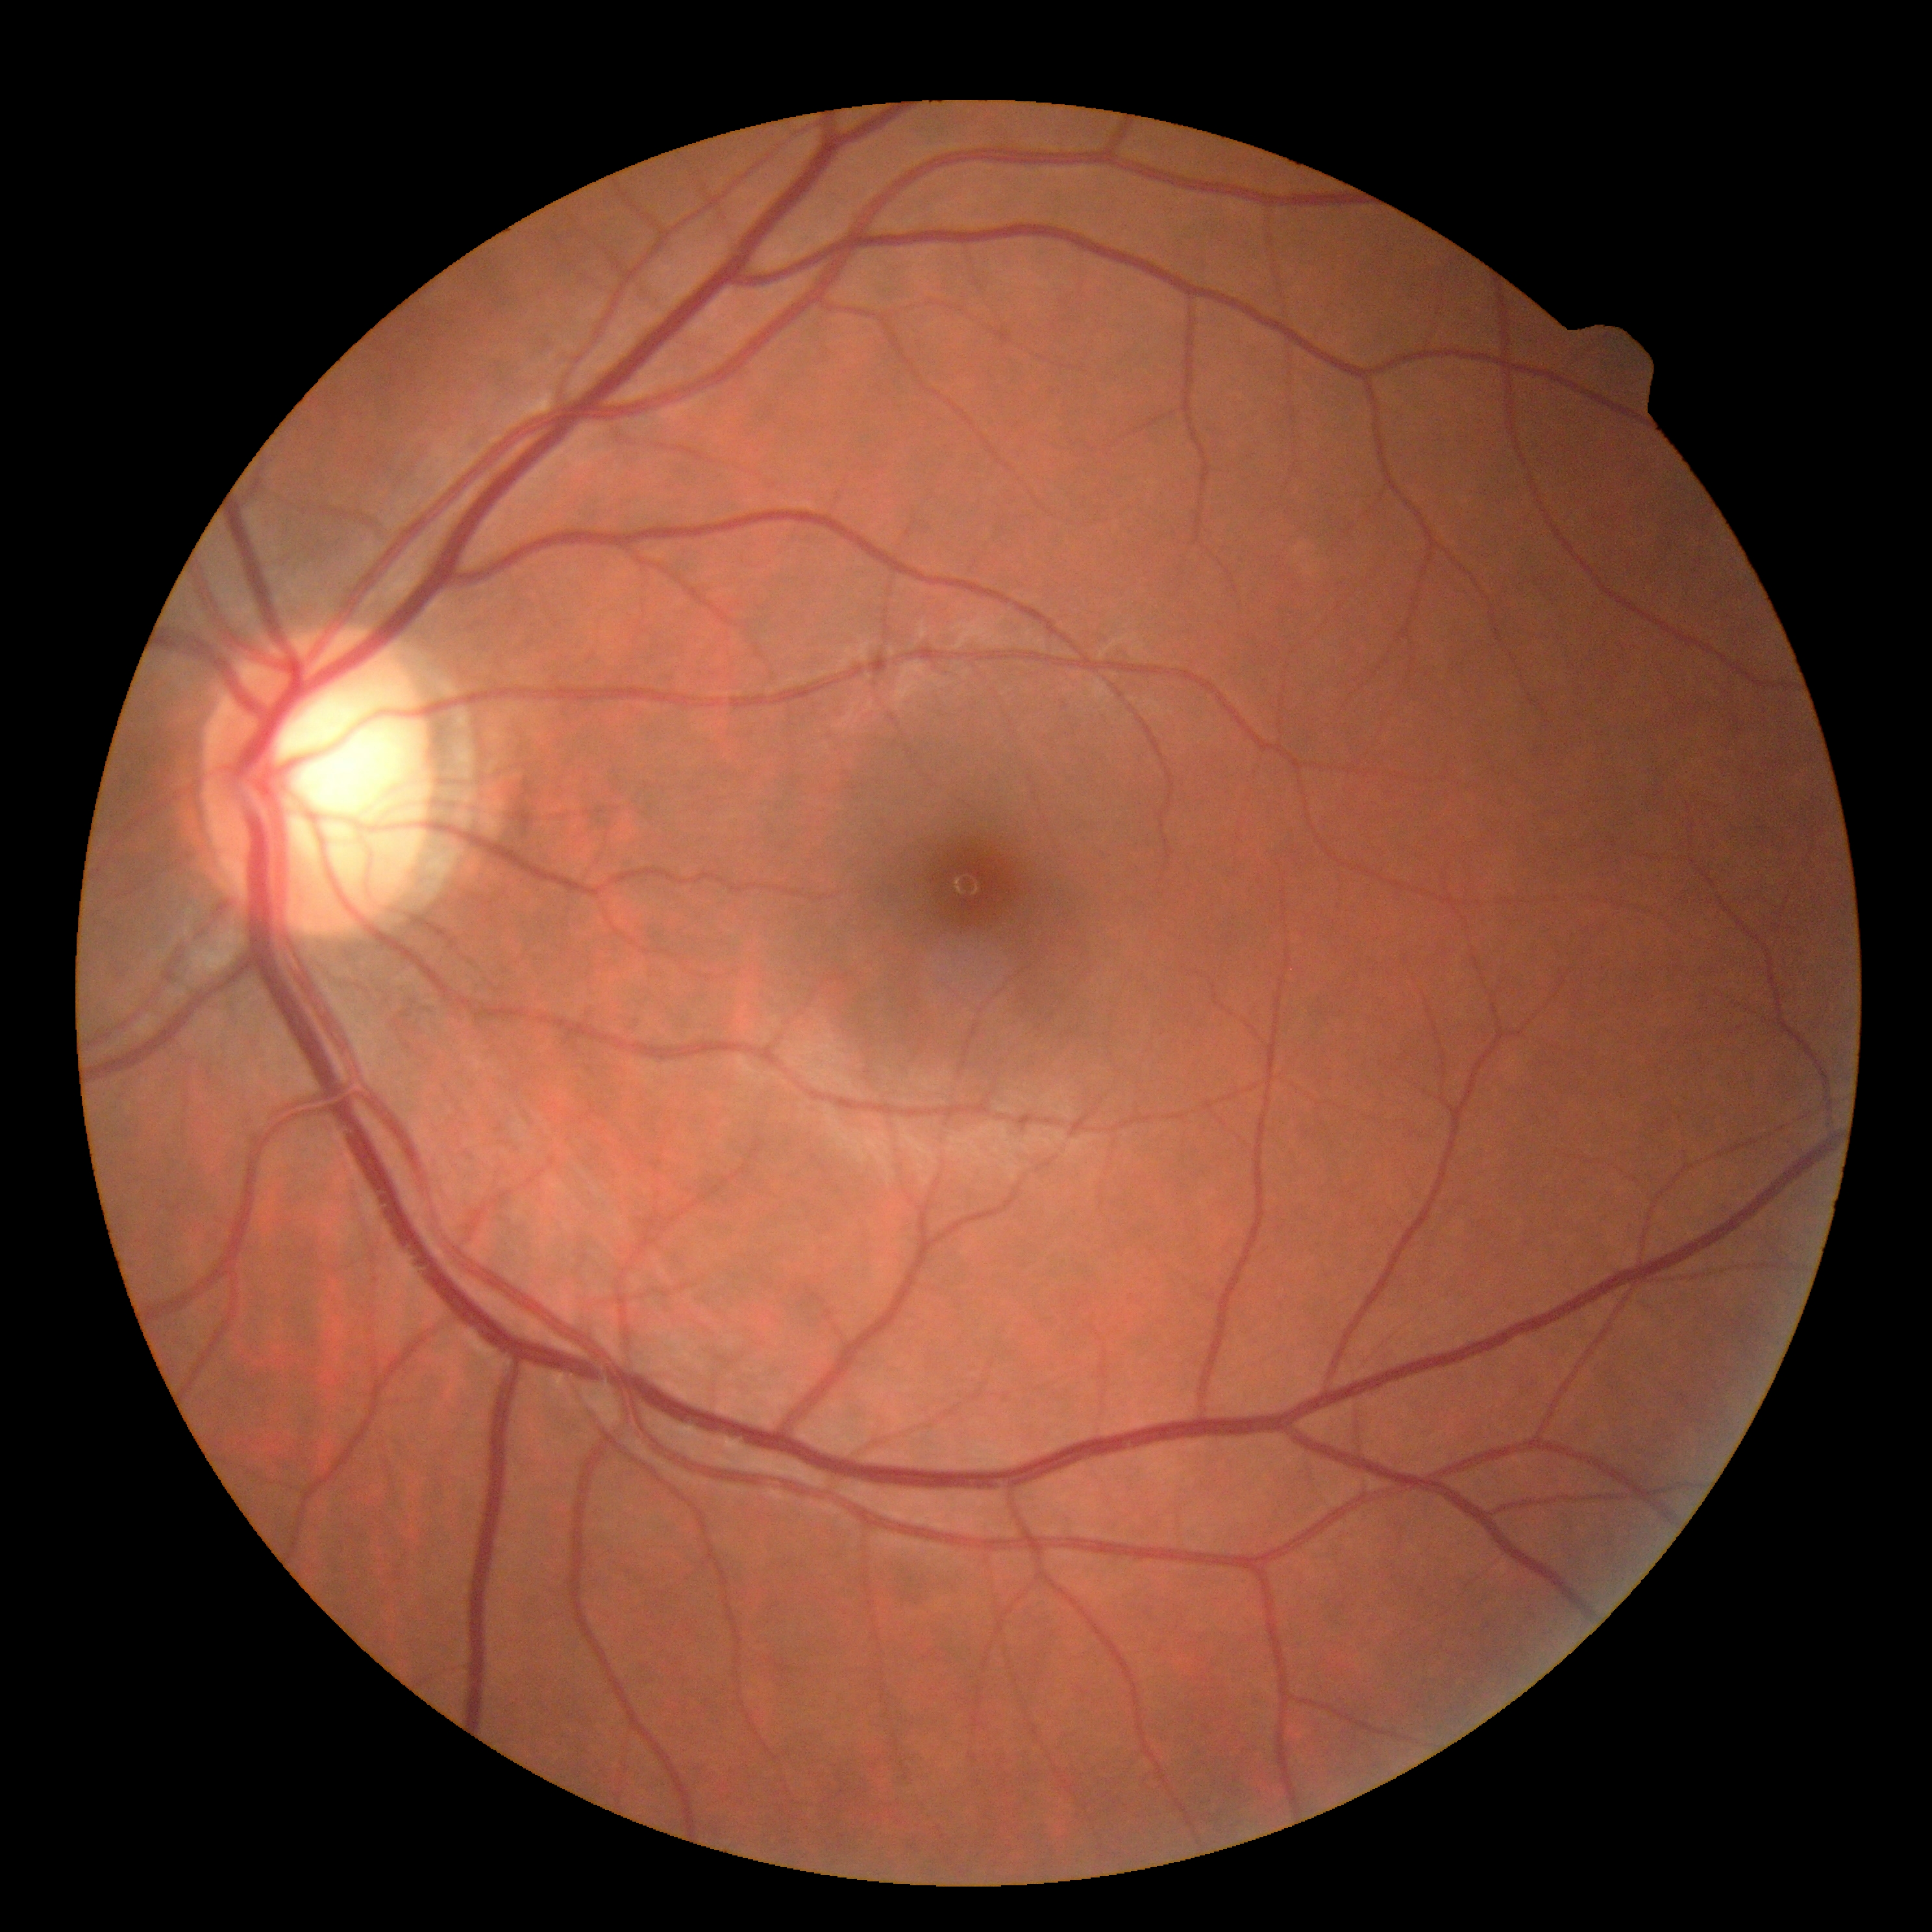
Diabetic retinopathy (DR): grade 0 (no apparent retinopathy).